Optic nerve head photograph; acquired with a Topcon TRC:
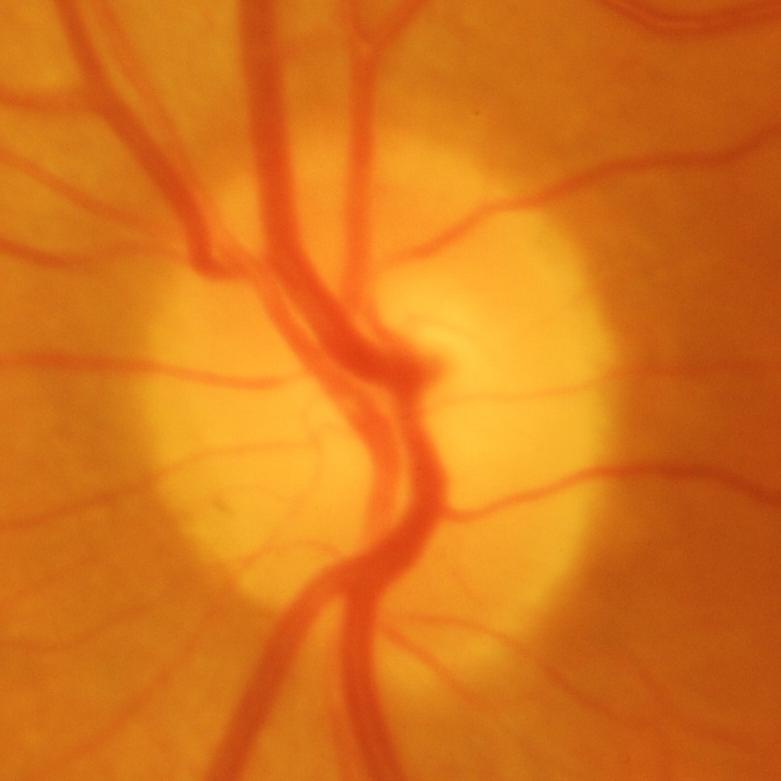 Q: Is glaucoma present?
A: Glaucomatous changes.